Acquired with a NIDEK AFC-230: 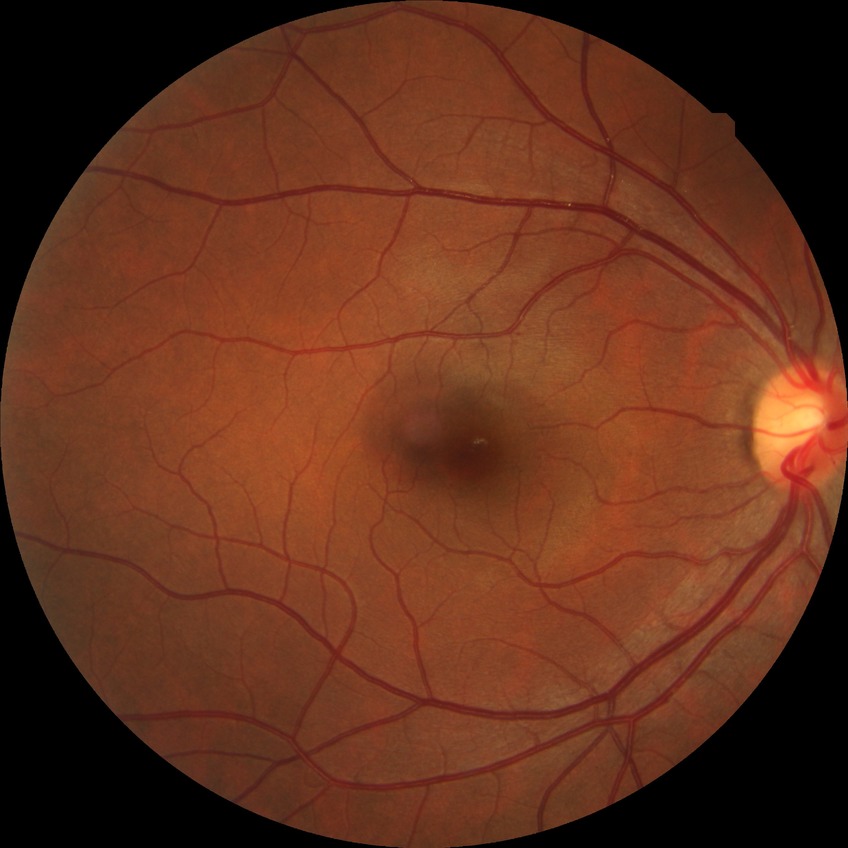 Diabetic retinopathy (DR): no diabetic retinopathy (NDR).